Image size 848x848; modified Davis grading.
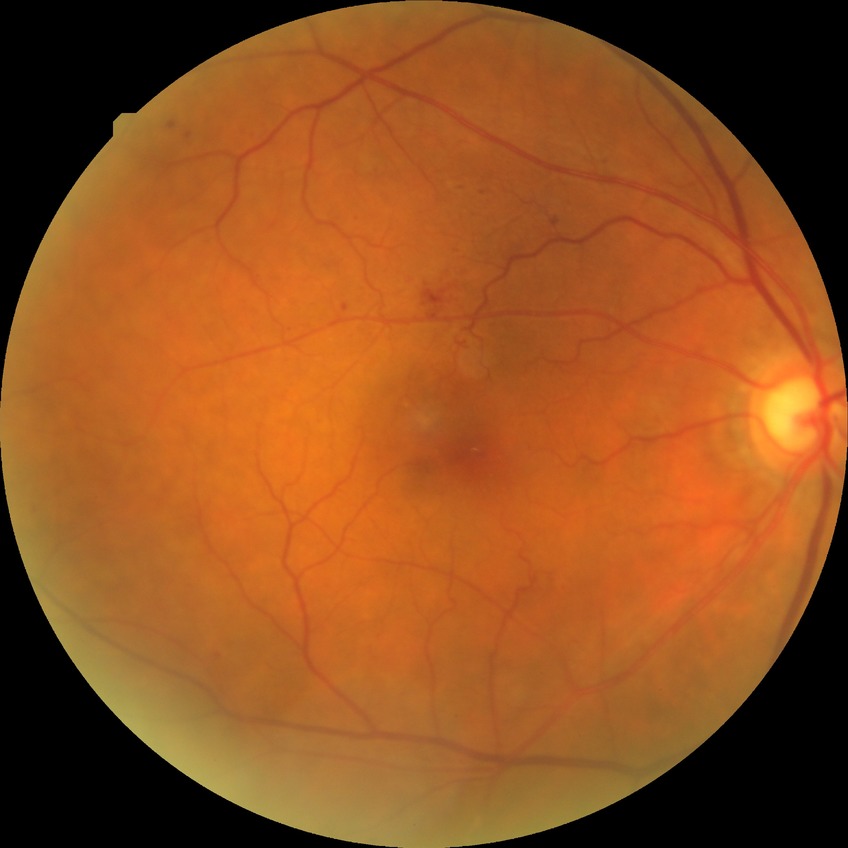
Davis stage is SDR.